Portable fundus camera image. 2212x1659
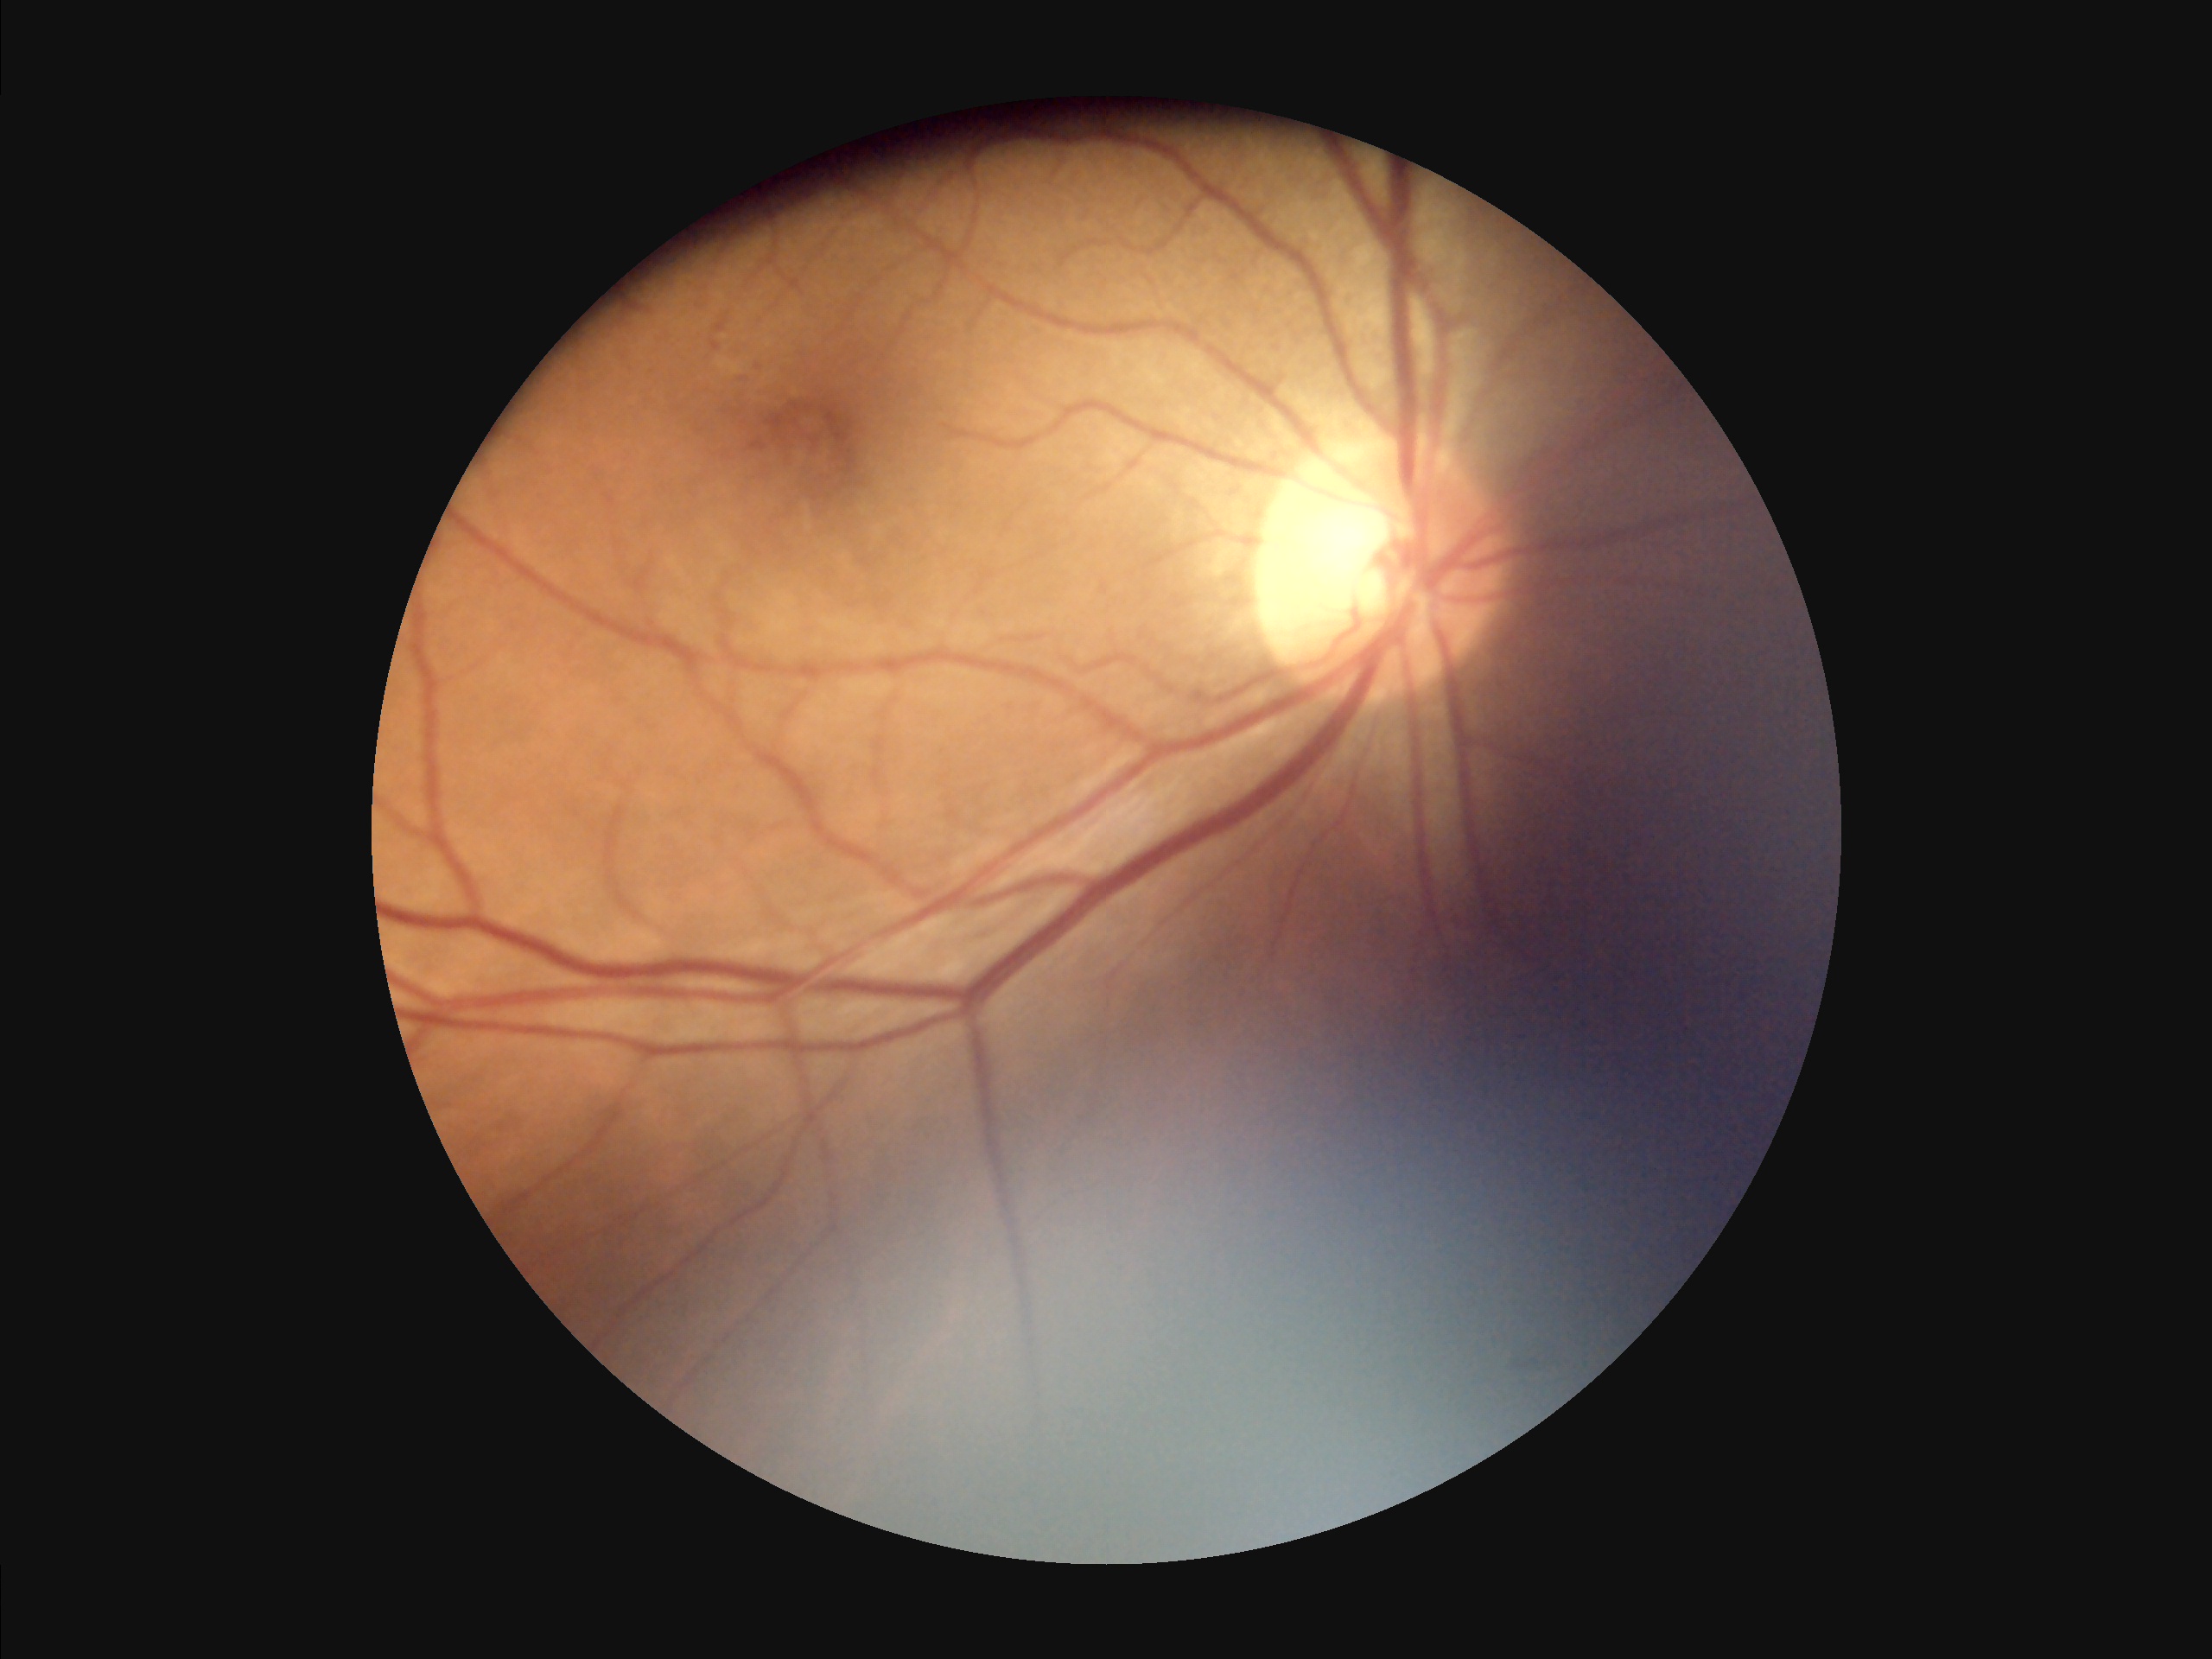
Image quality assessment:
- clarity: out of focus
- overall: low
- illumination/color: poor
- contrast: adequate